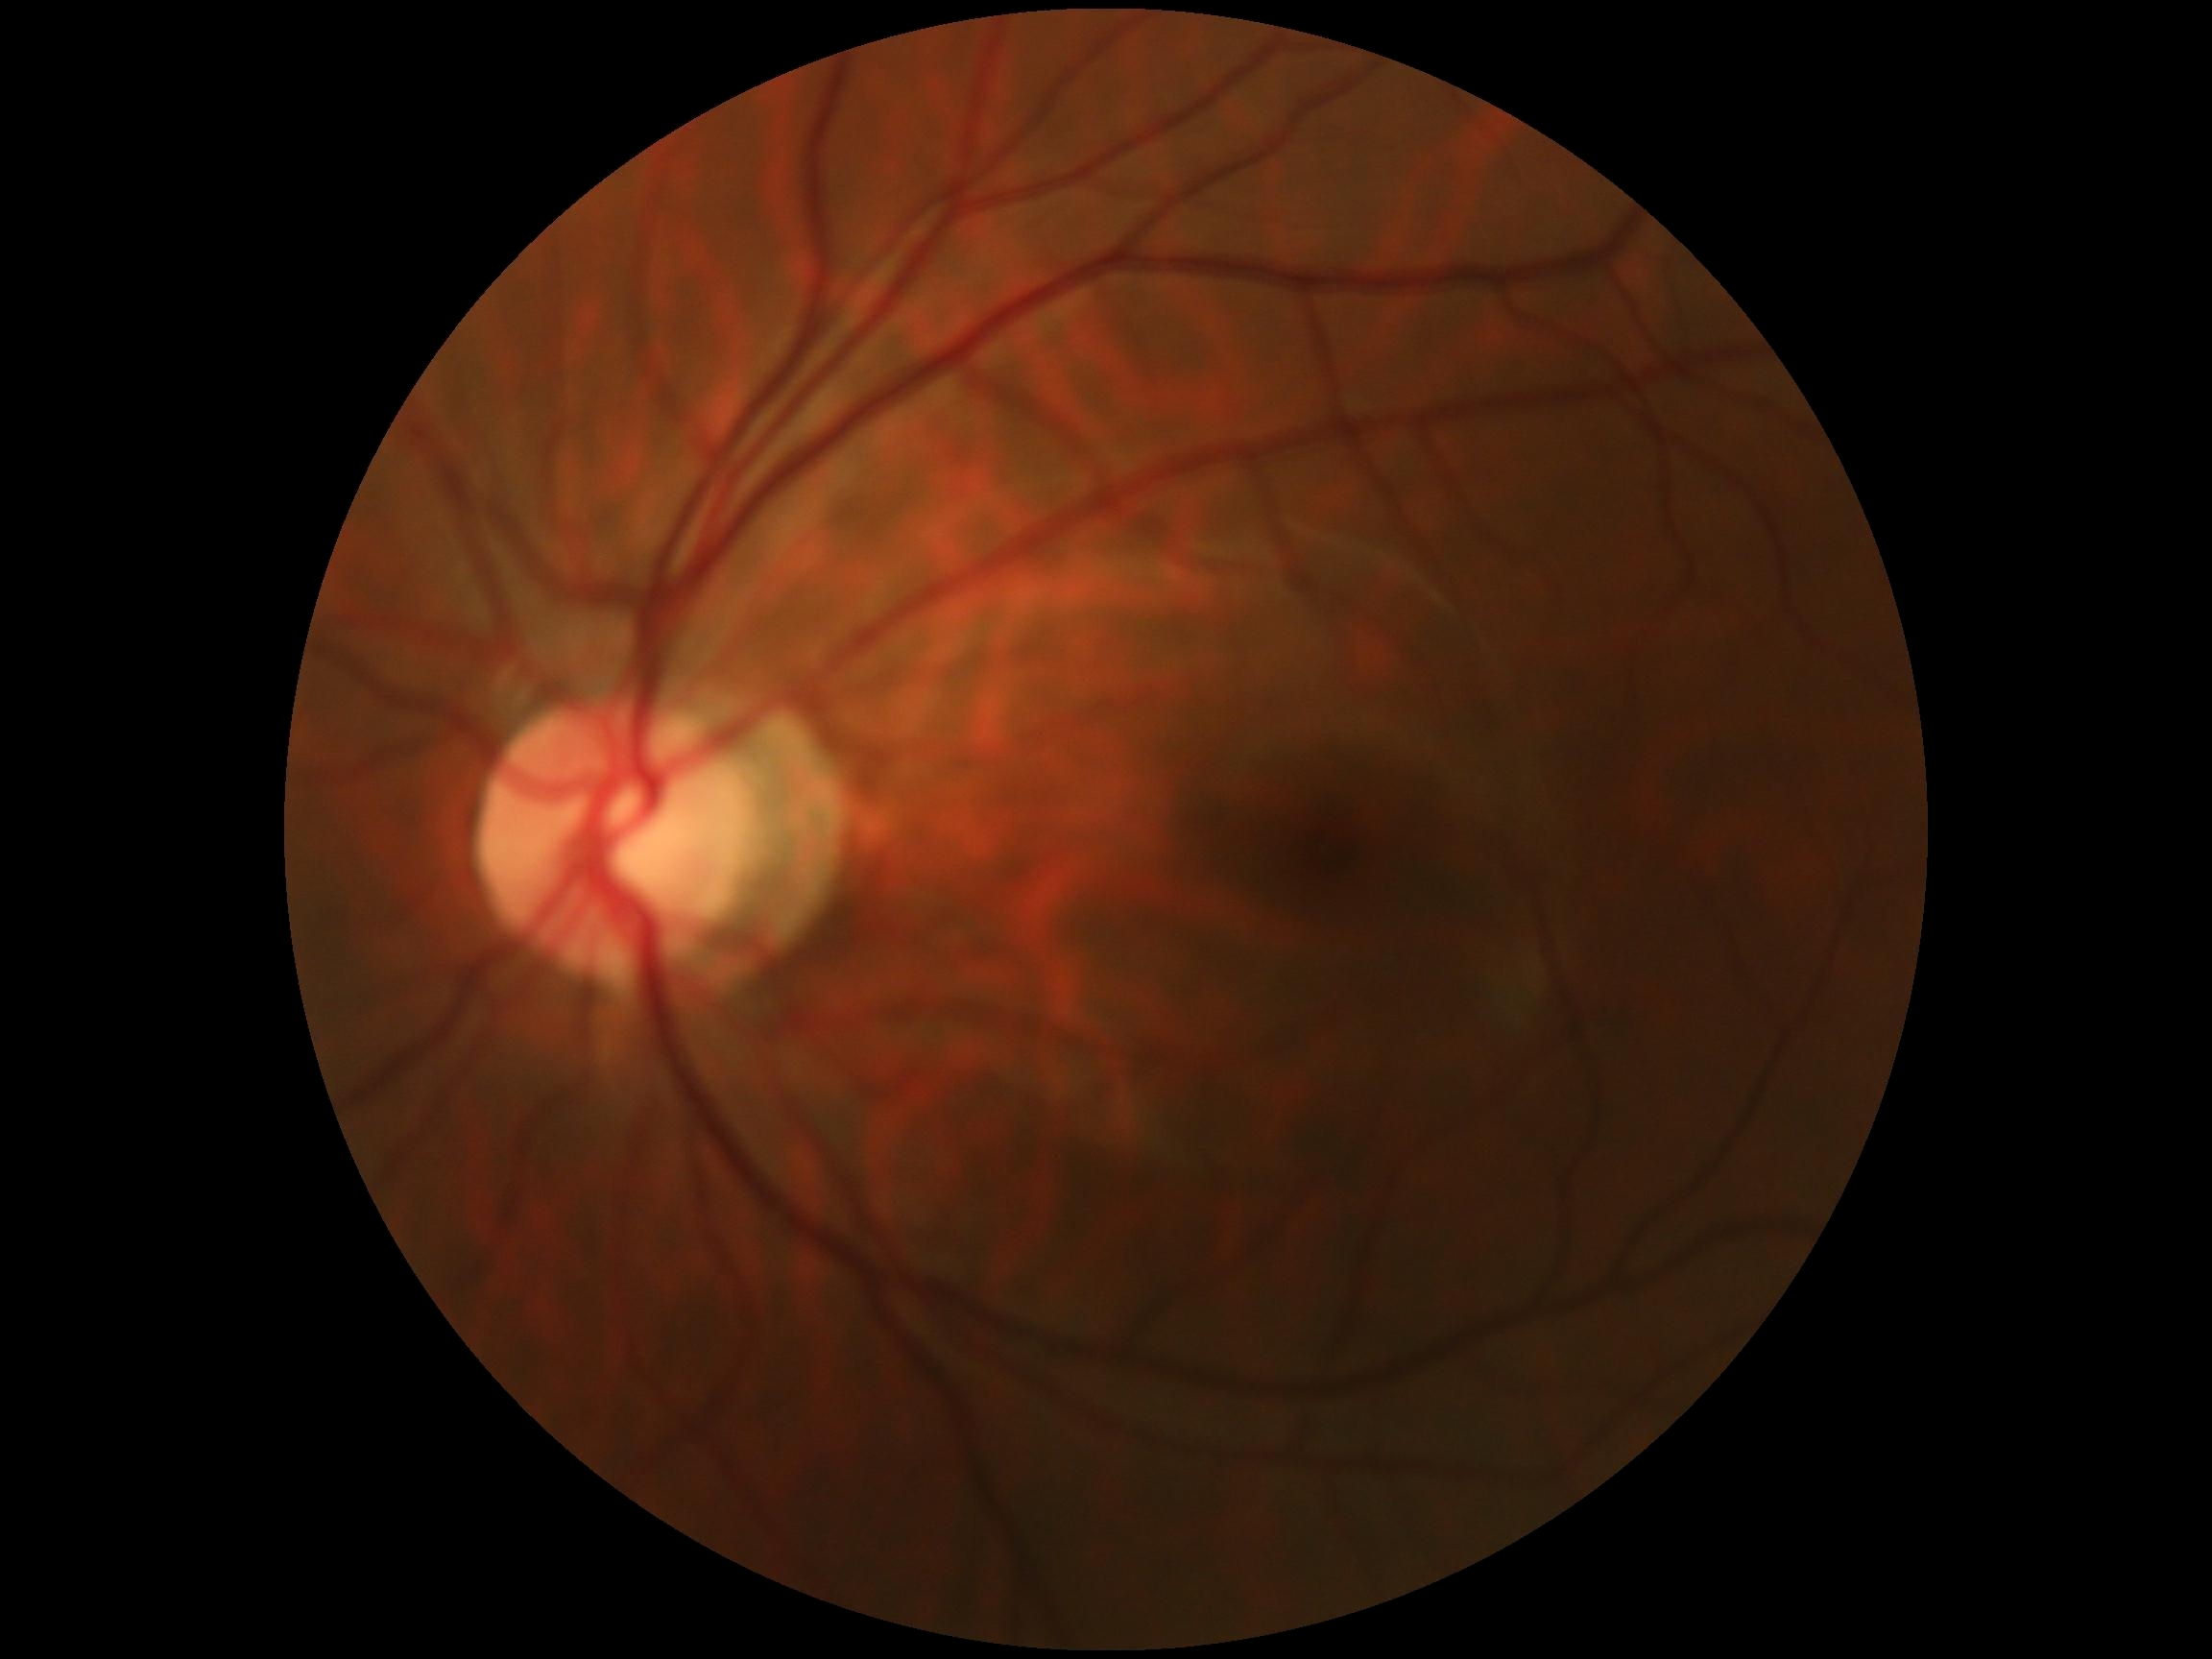 Retinopathy: grade 0 (no apparent retinopathy).